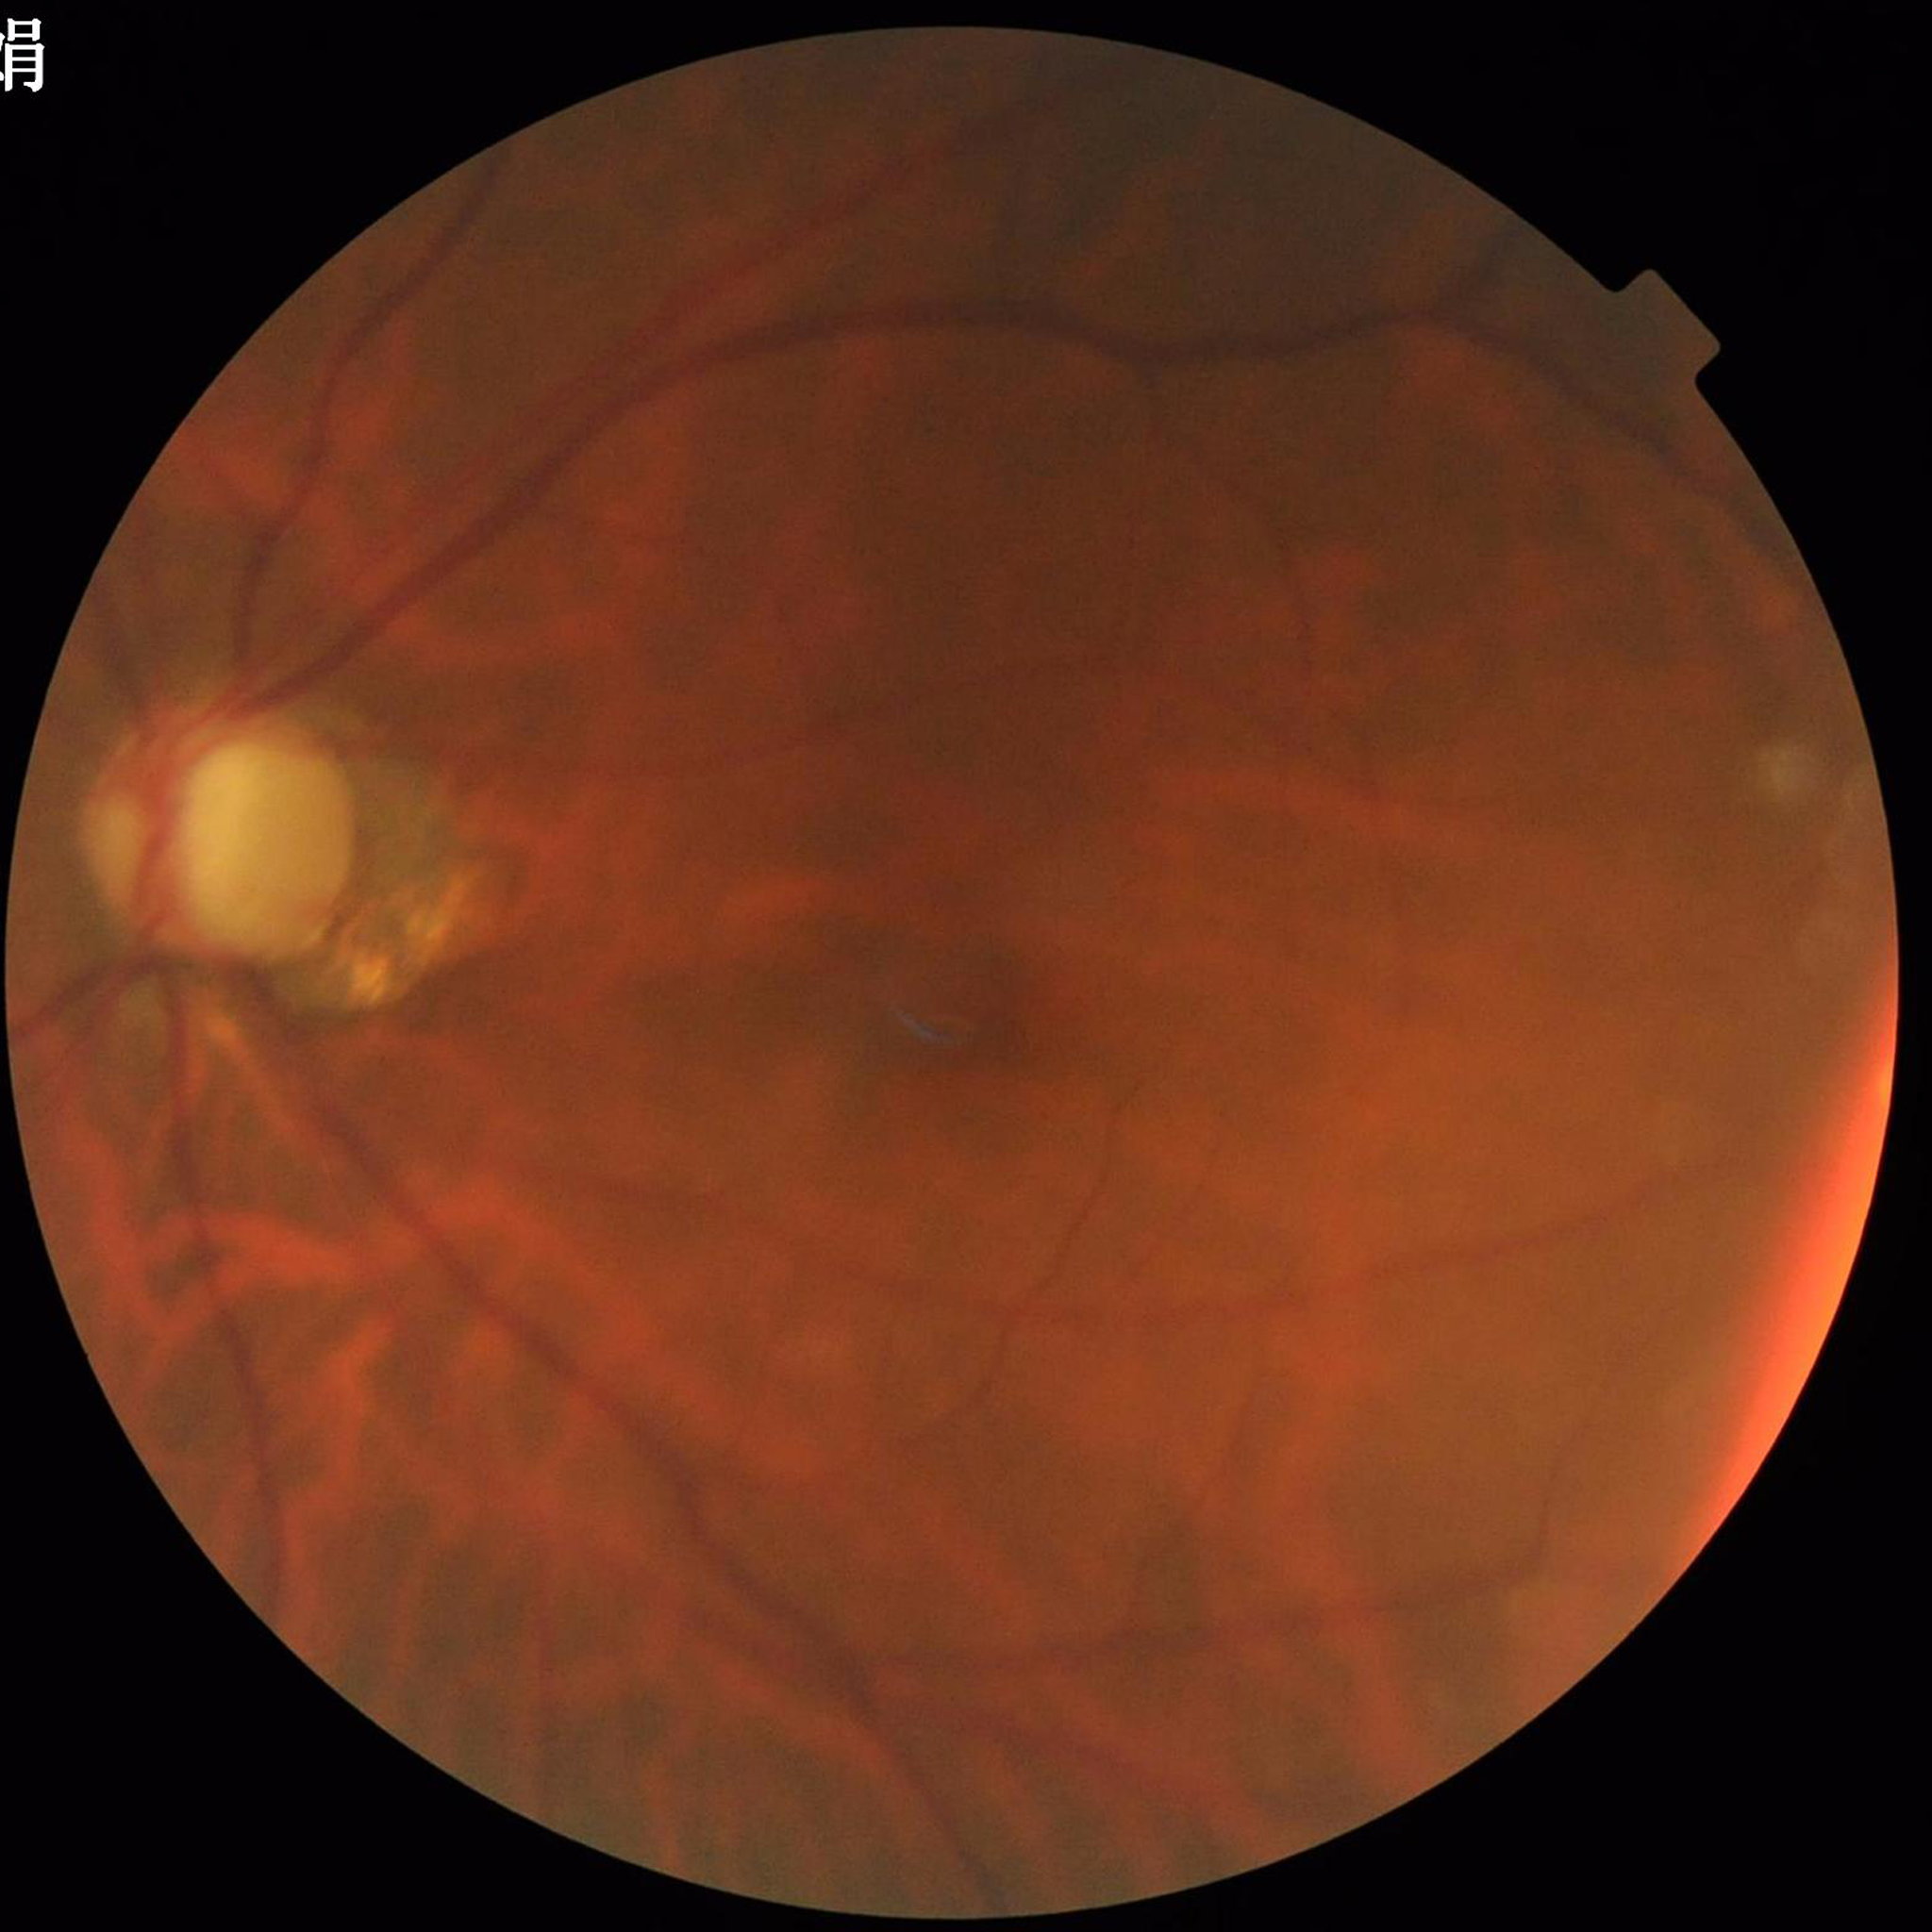

This fundus photograph is from a patient diagnosed with glaucoma.